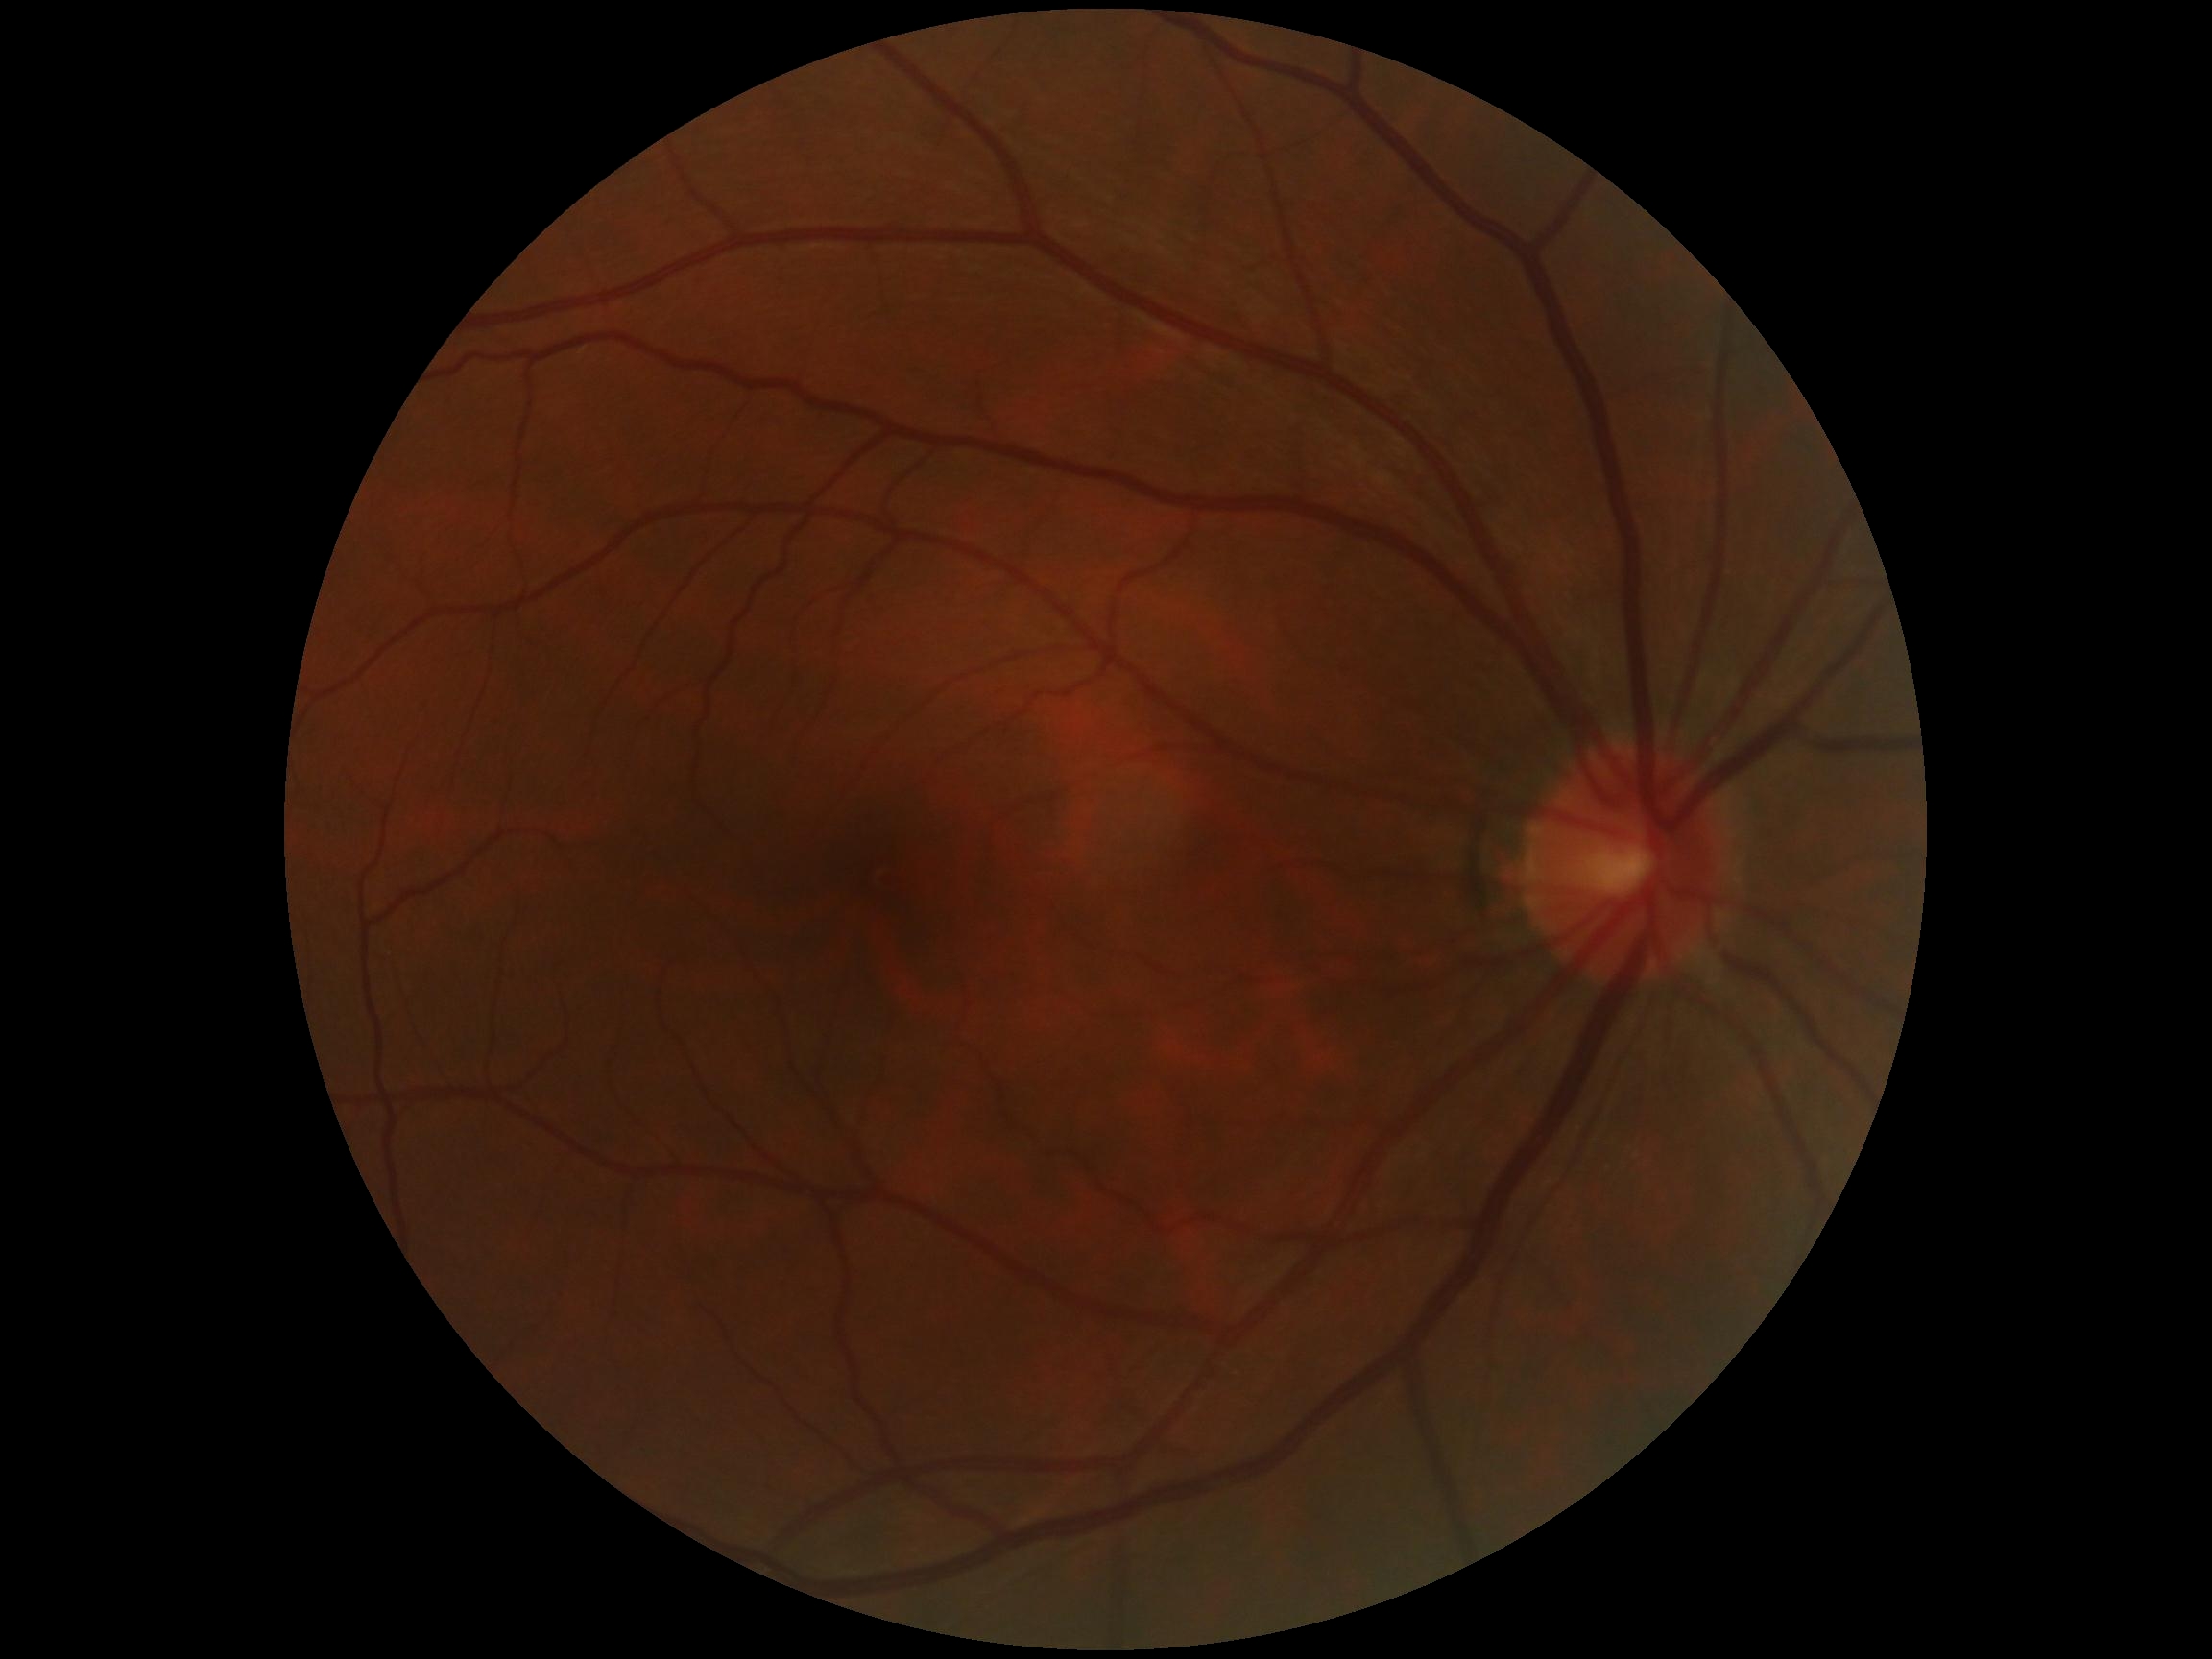

Annotations:
– DR — no apparent retinopathy (grade 0)